No pharmacologic dilation. Acquired with a NIDEK AFC-230:
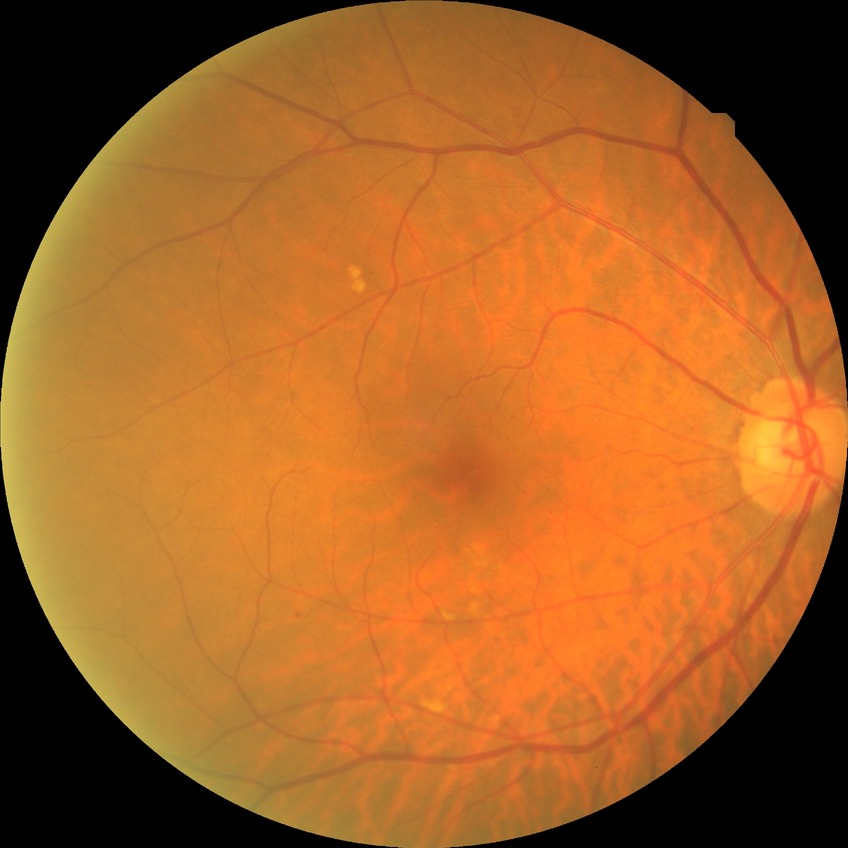

Annotations:
- Davis grade — SDR